UWF retinal mosaic · 1924 x 1556 pixels — 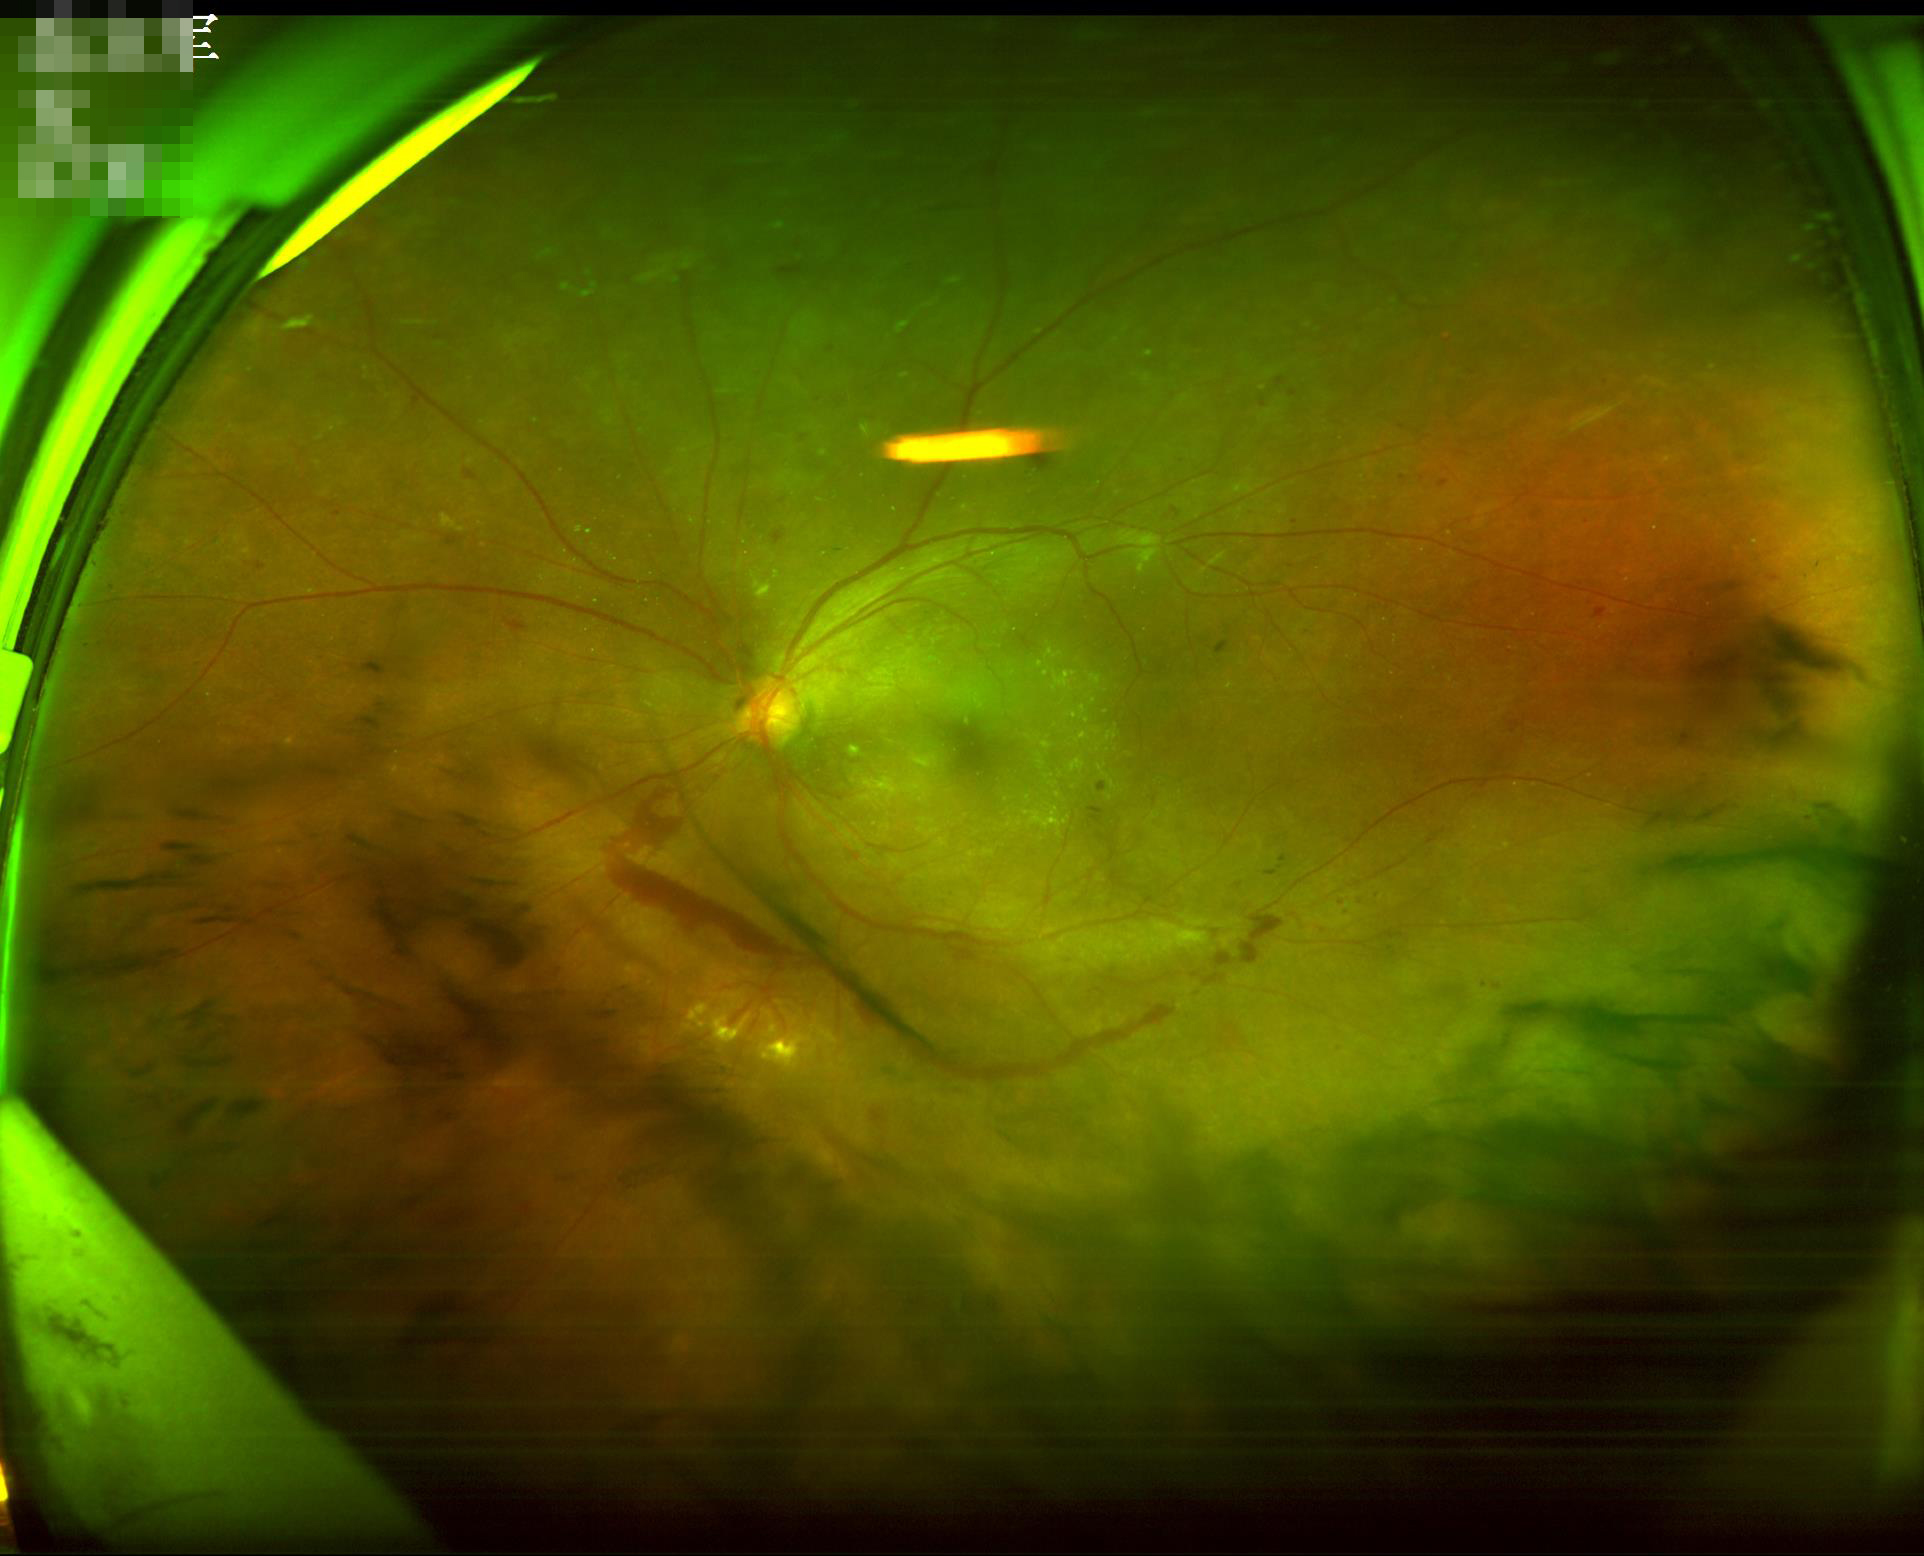 Clarity = out of focus | Illumination = satisfactory | Overall = acceptable.